Diabetic retinopathy graded by the modified Davis classification; no pharmacologic dilation
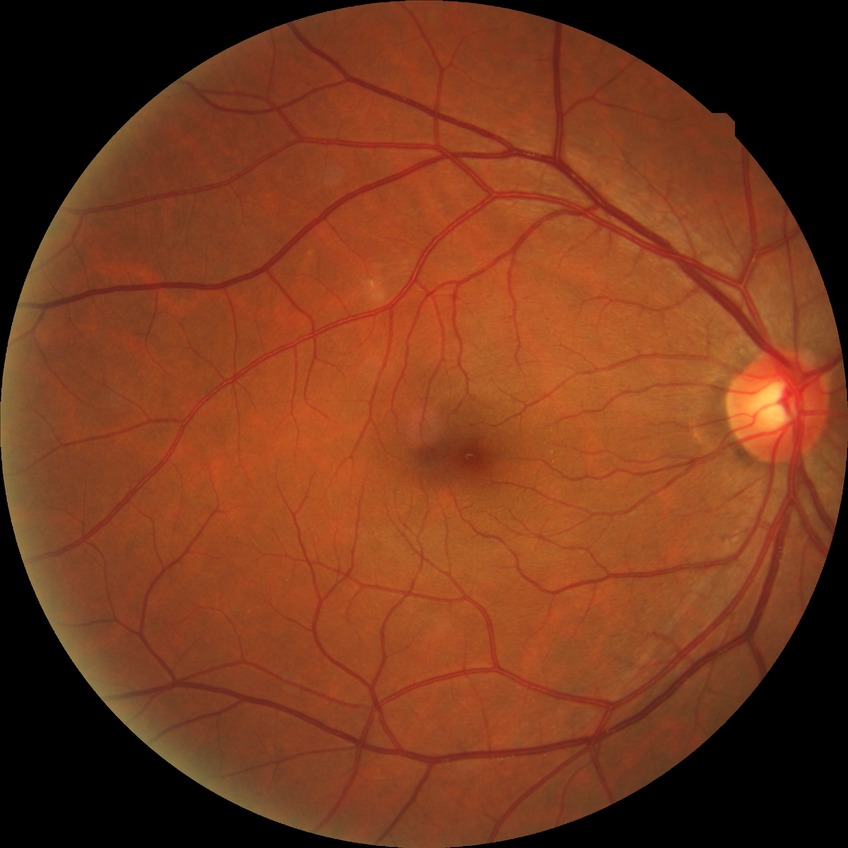

Diabetic retinopathy (DR): NDR (no diabetic retinopathy).